Captured on a Nidek AFC-330 fundus camera:
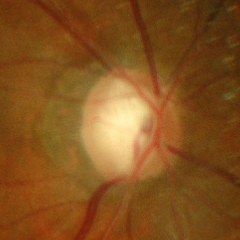
Q: Does this eye have glaucoma?
A: Yes — advanced glaucomatous optic neuropathy.